Wide-field fundus photograph from neonatal ROP screening.
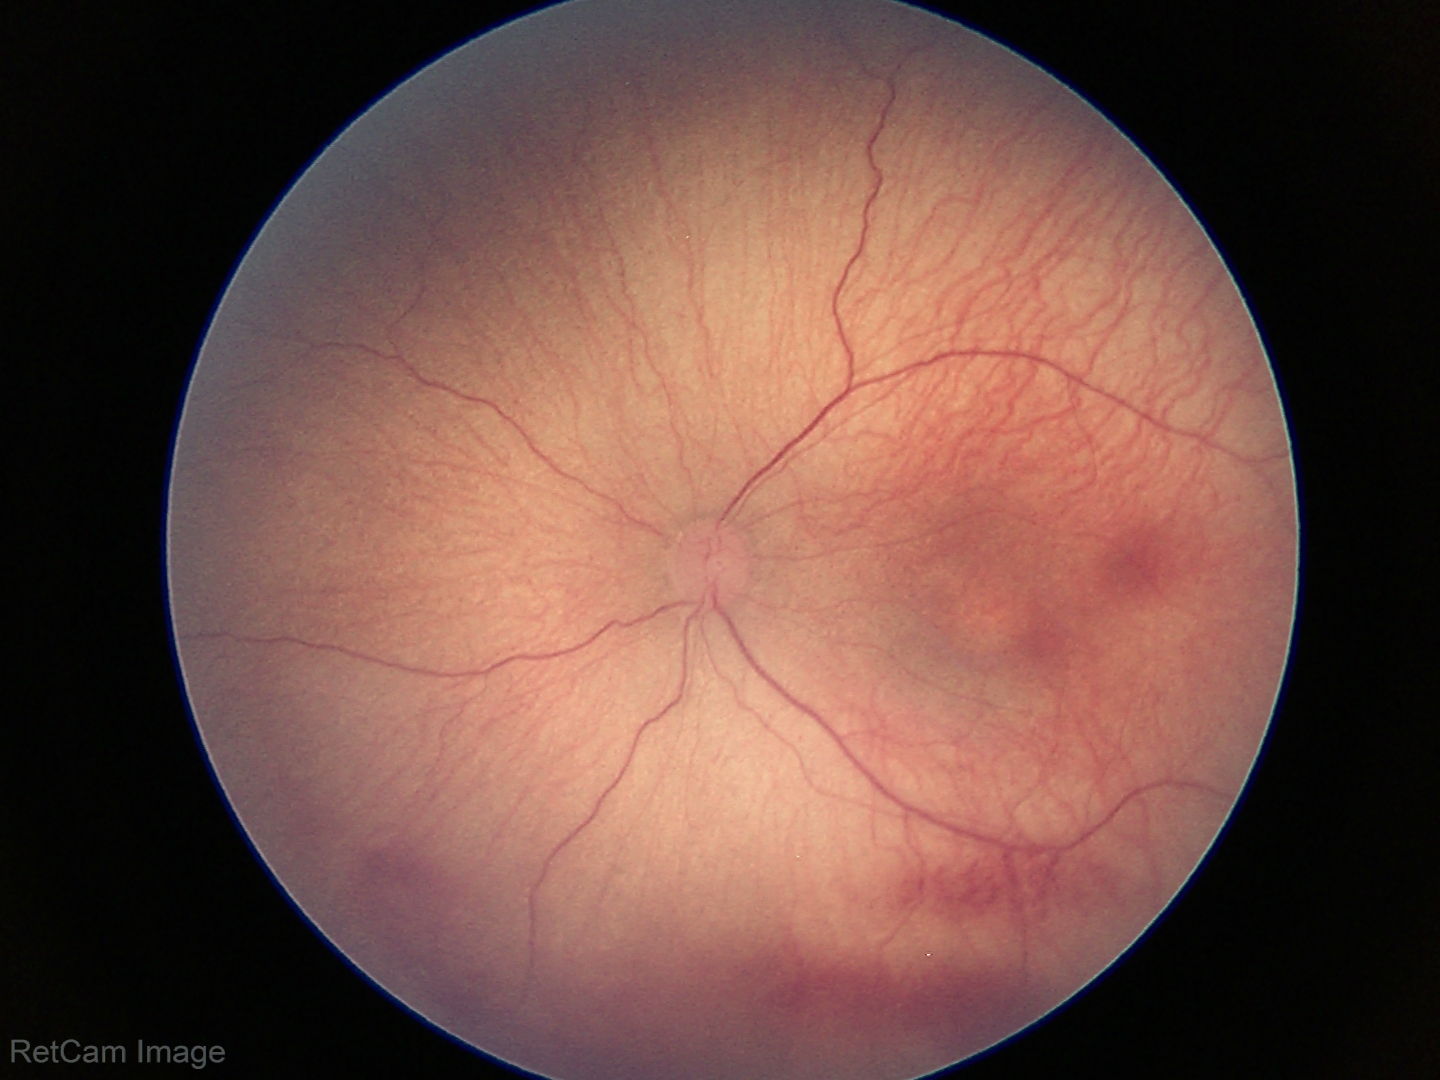
Impression: retinopathy of prematurity stage 1 | no plus disease.